Infant wide-field retinal image:
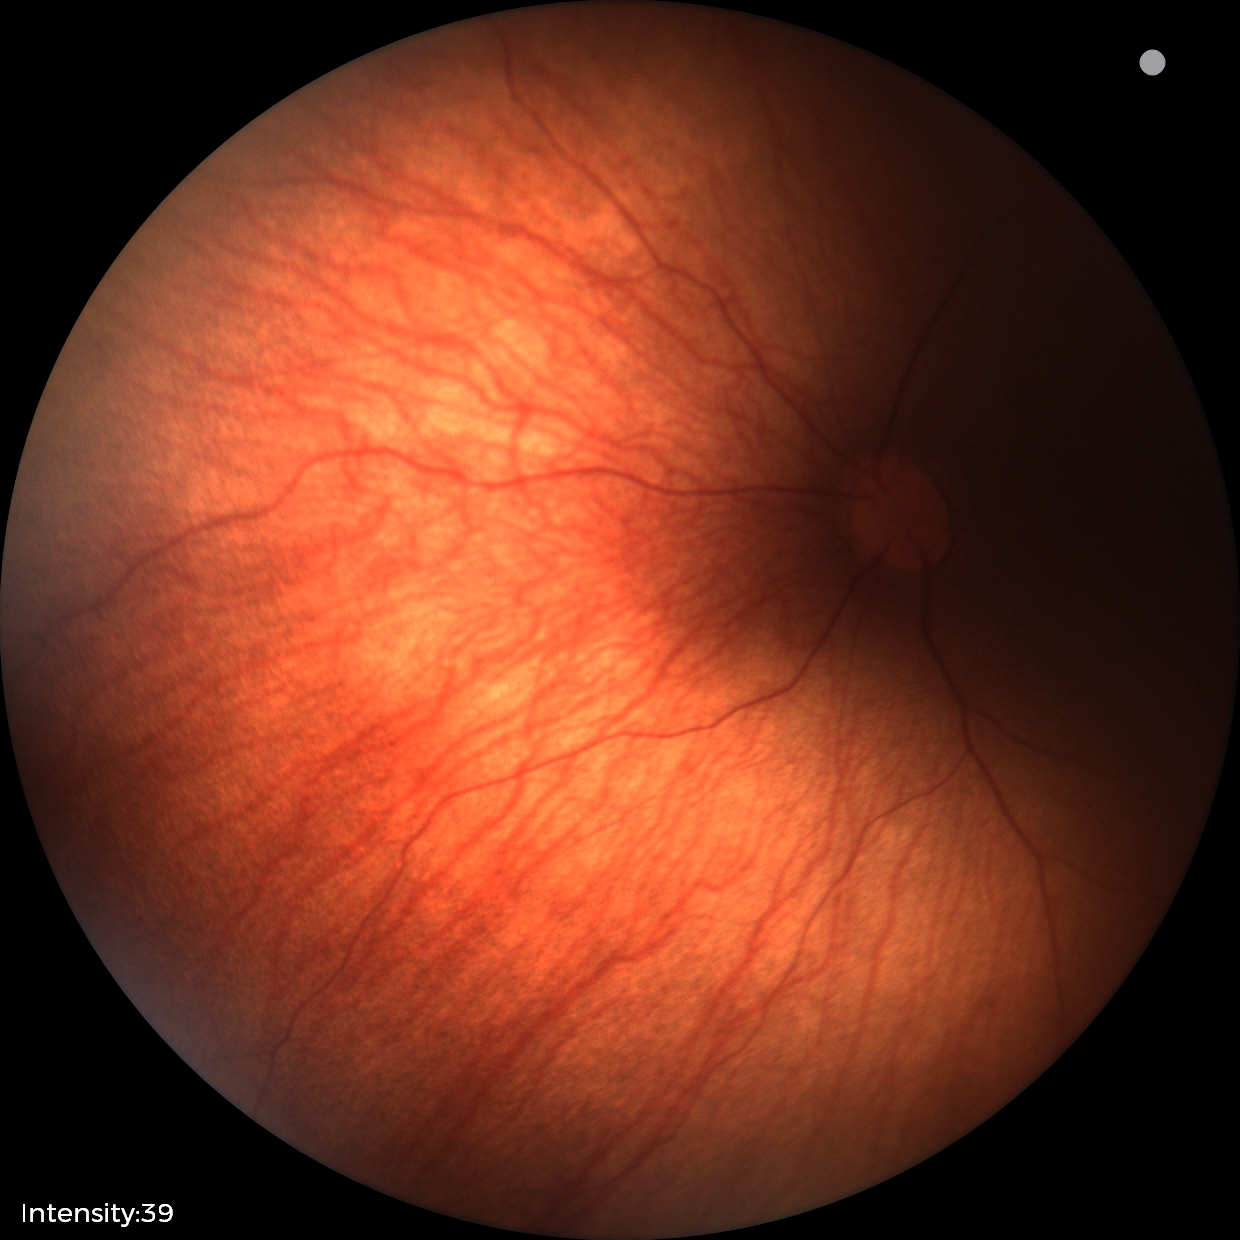

Assessment: retinal hemorrhages.